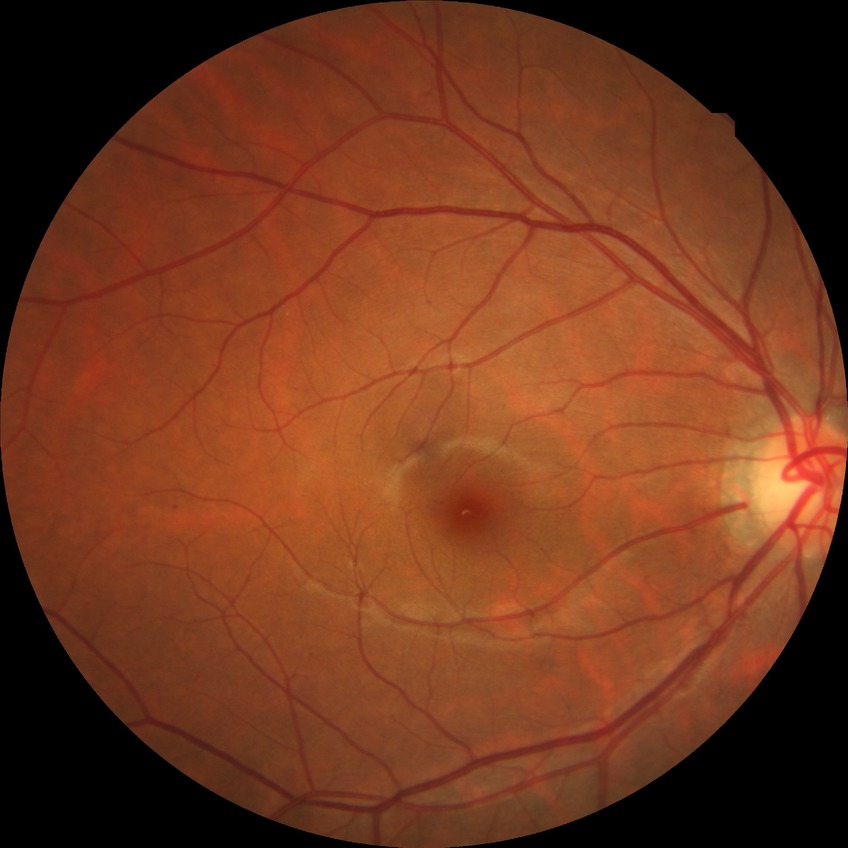

Modified Davis classification is simple diabetic retinopathy.